848x848; NIDEK AFC-230 fundus camera — 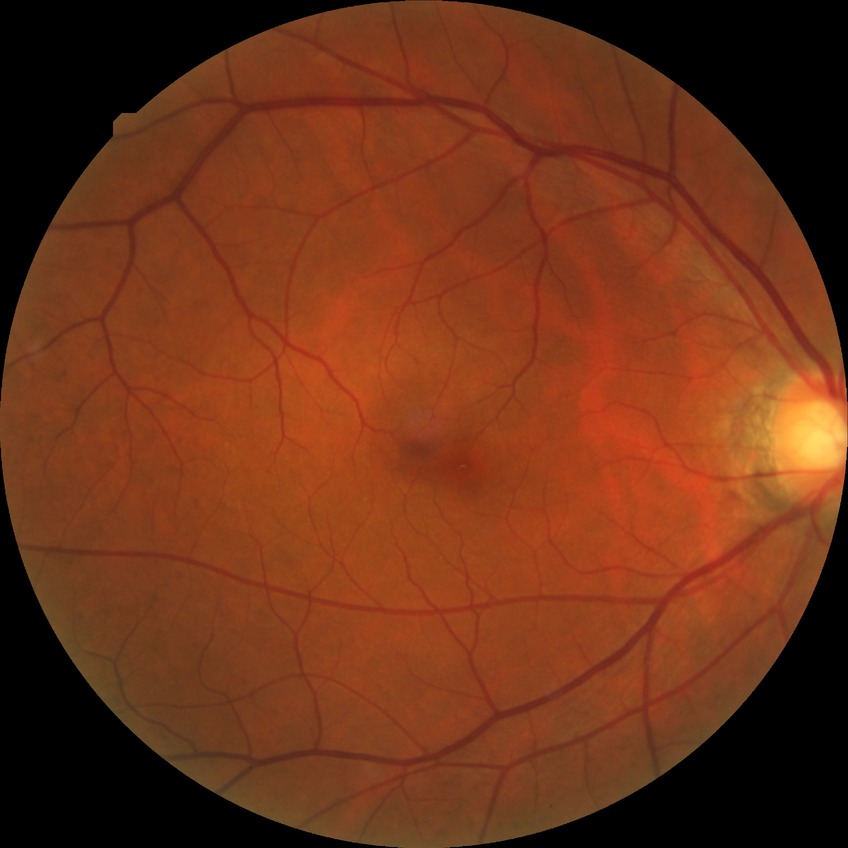
davis_grade: no diabetic retinopathy (NDR)